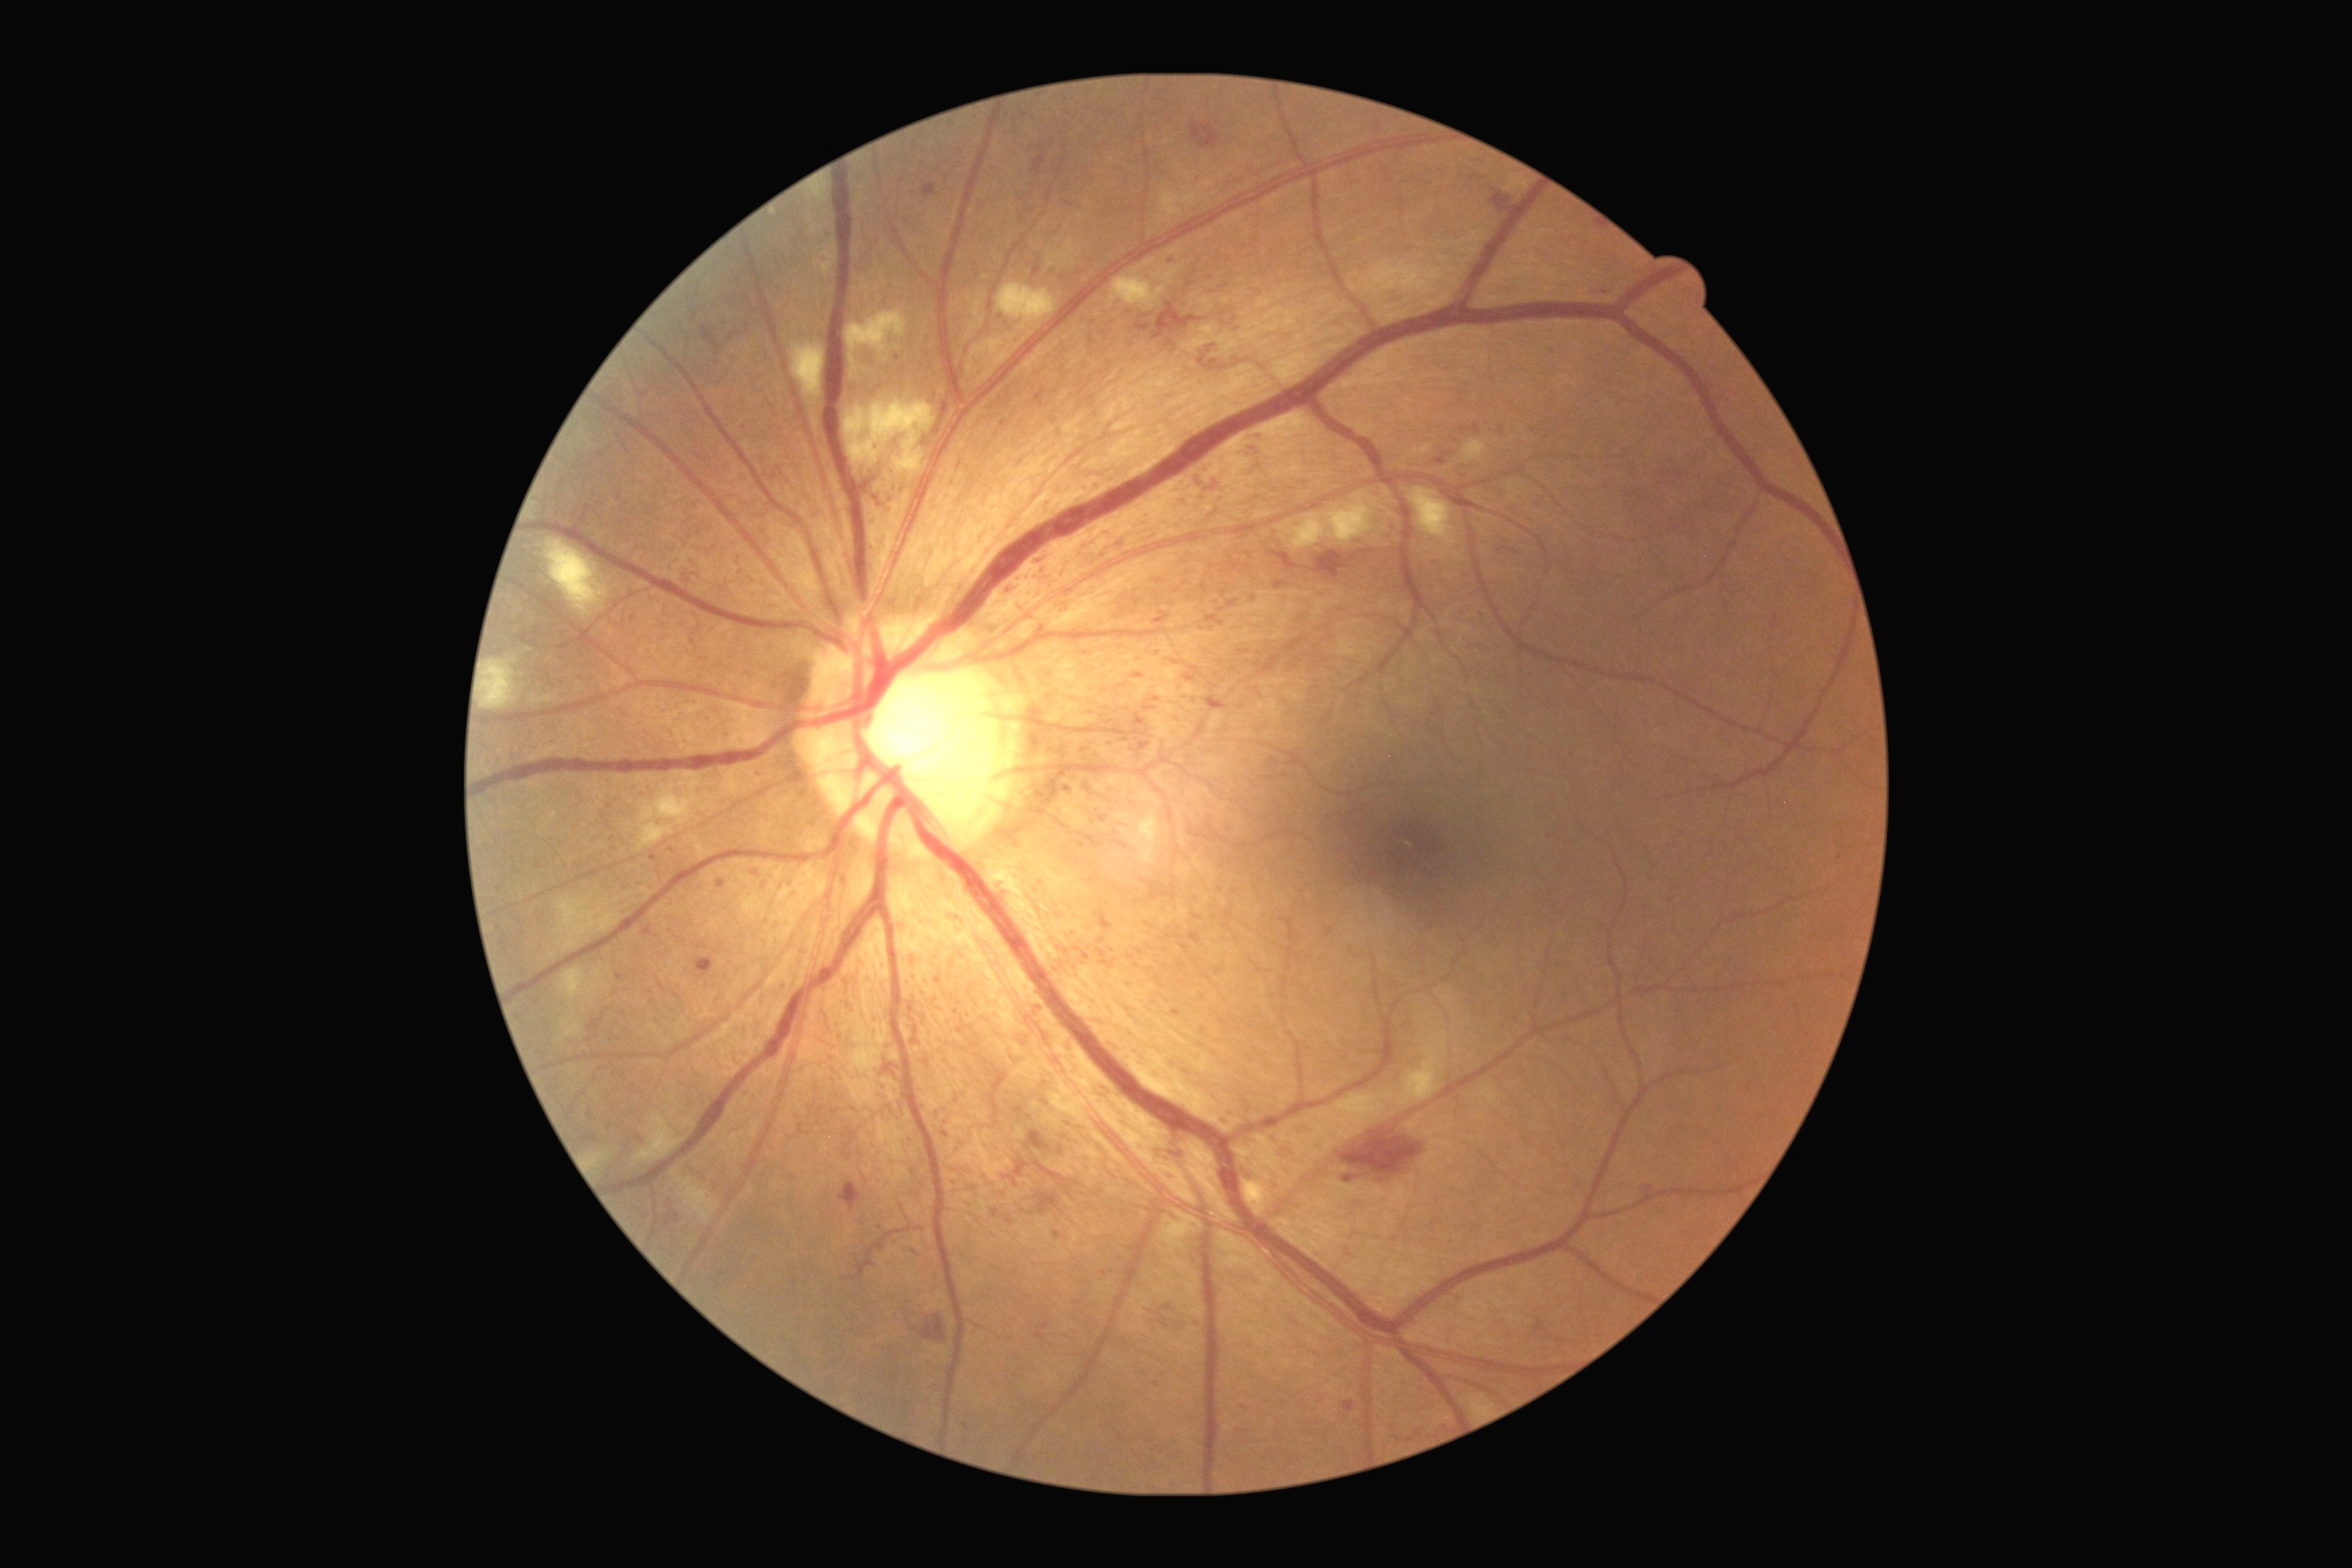 Diabetic retinopathy (DR): grade 3 (severe NPDR)
A subset of detected lesions:
microaneurysms (MAs) (subset) = [1052,1231,1063,1239], [823,231,830,244], [1097,939,1106,945], [1135,315,1152,333], [1239,651,1248,654], [1435,458,1446,466], [1034,554,1046,567], [1171,1010,1181,1017], [1141,741,1152,752]
Additional small MAs near x=1104, y=1273, x=1550, y=837, x=1156, y=1384, x=1502, y=427, x=1111, y=1271, x=1140, y=953, x=1082, y=845, x=1005, y=423, x=721, y=884